Color fundus photograph; 45° field of view; 2352x1568px.
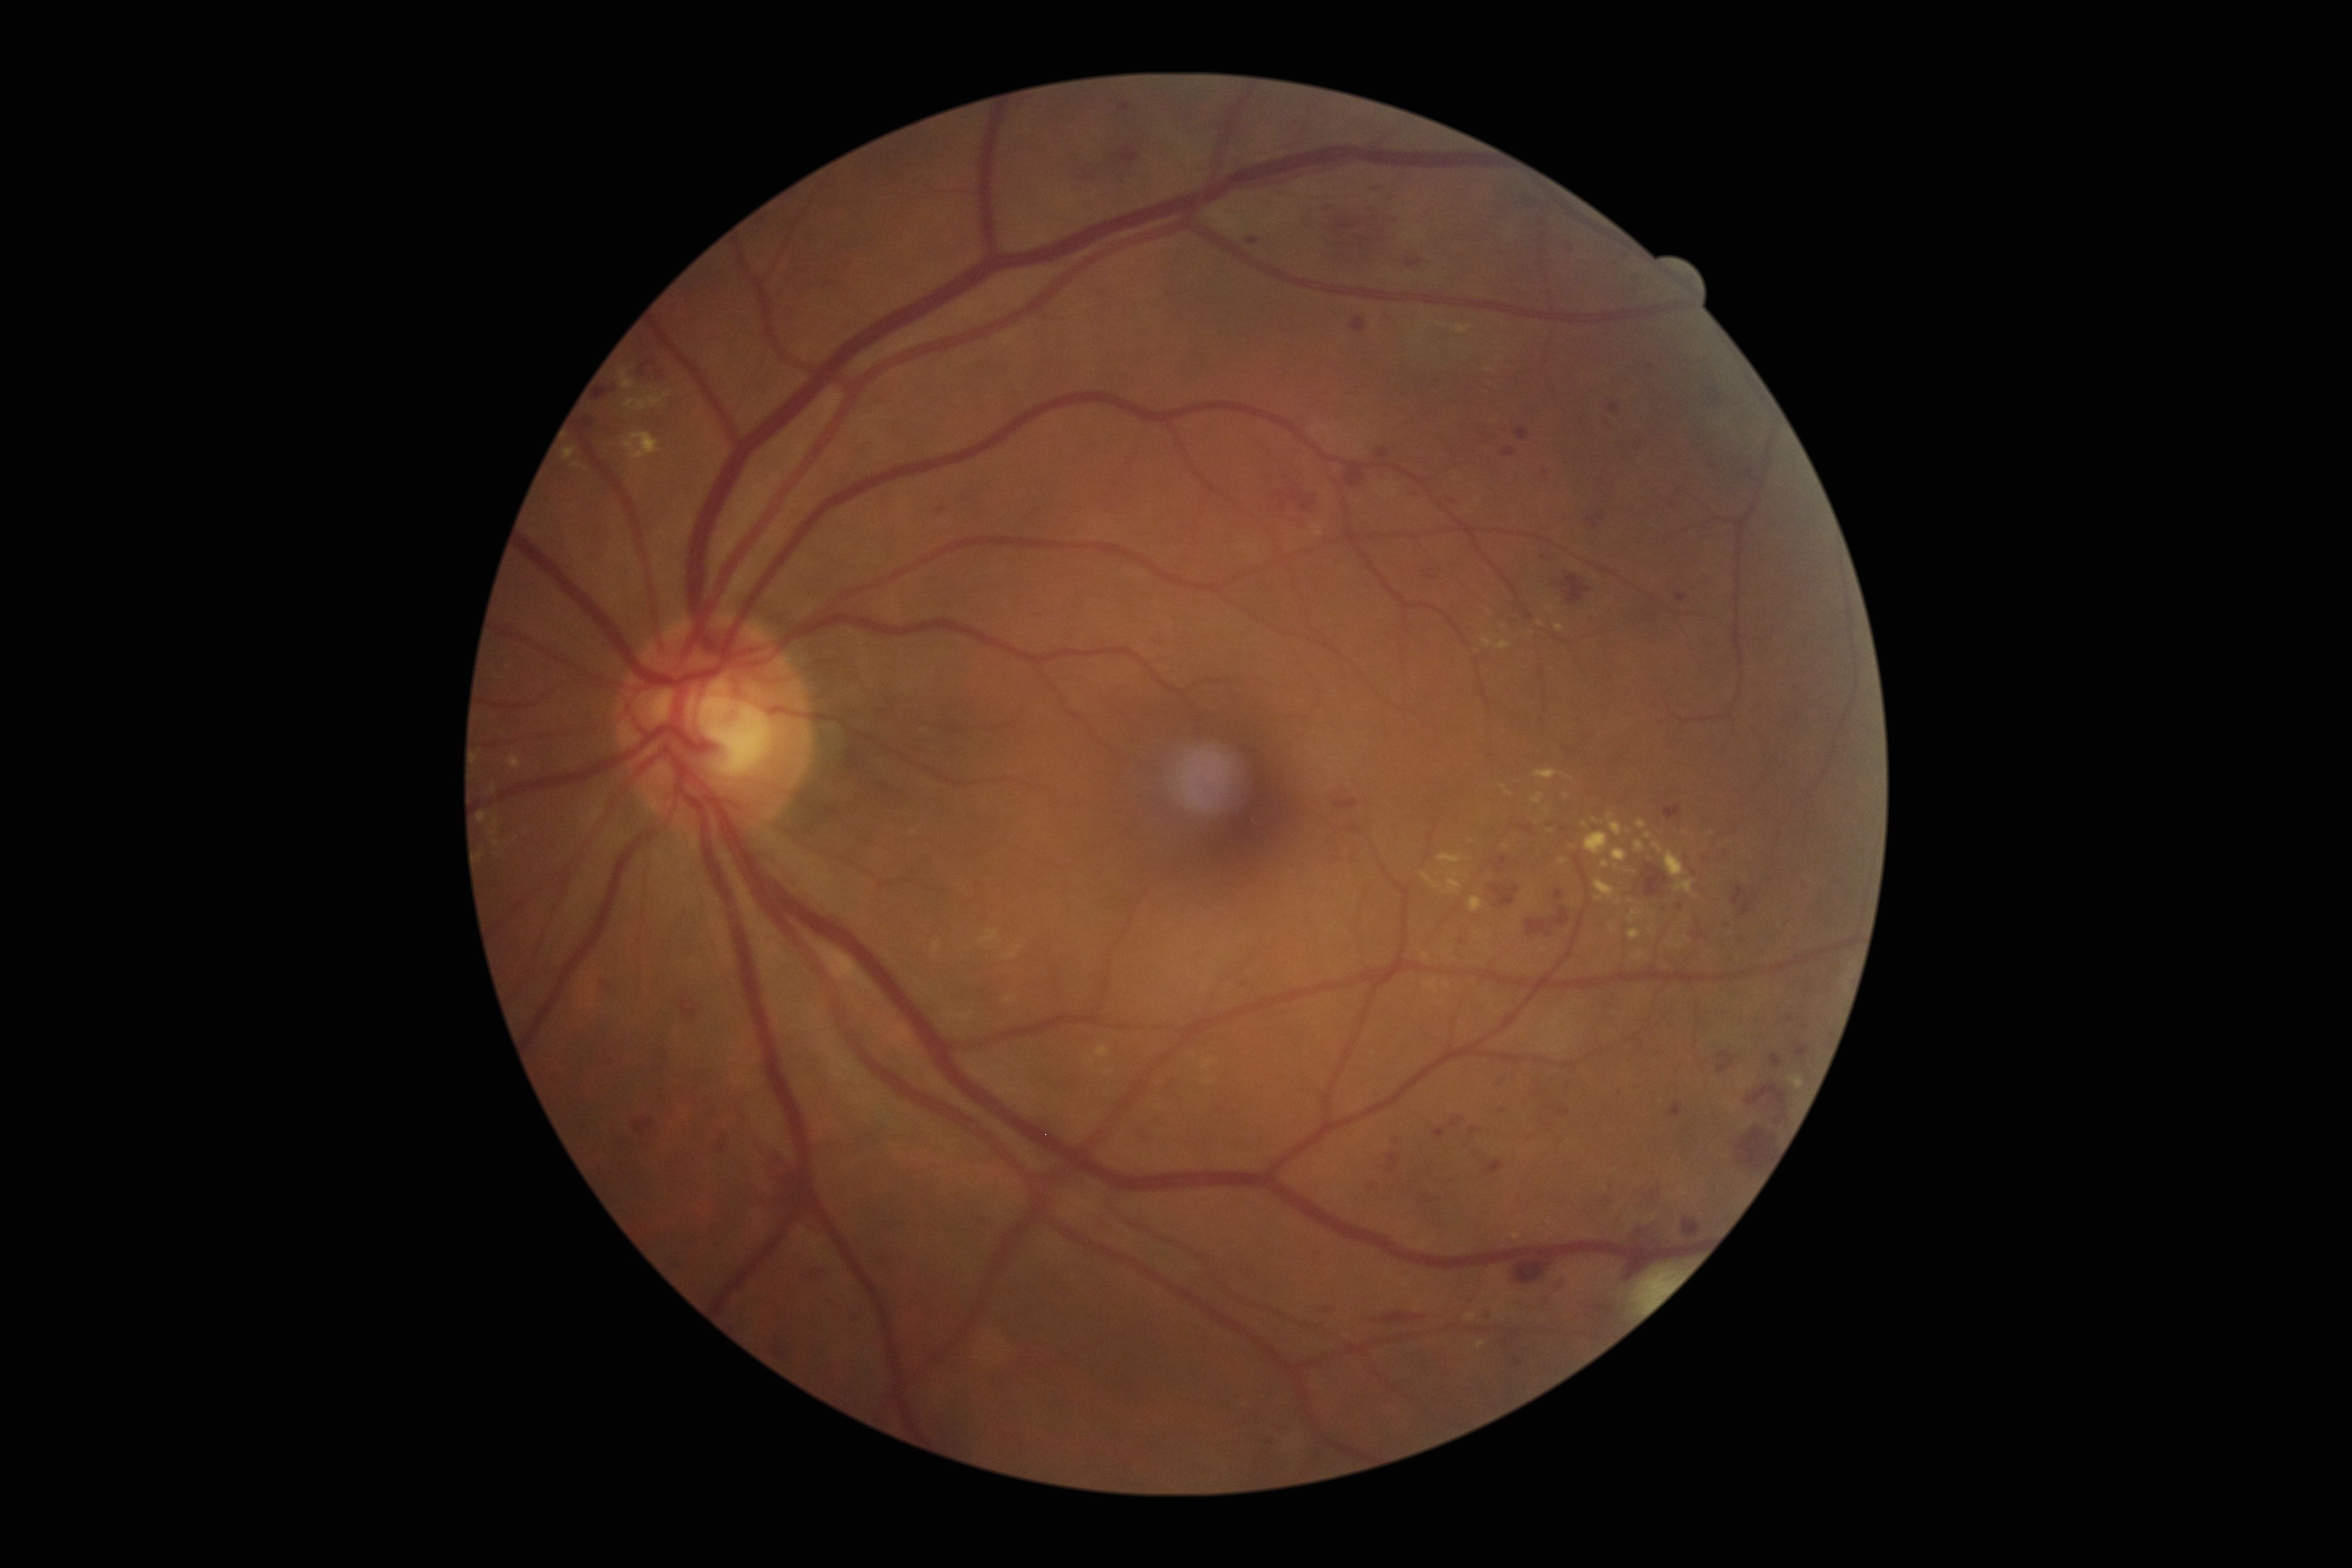

diabetic retinopathy (DR)@severe NPDR (grade 3); DR class@non-proliferative diabetic retinopathy.